Retinal fundus photograph:
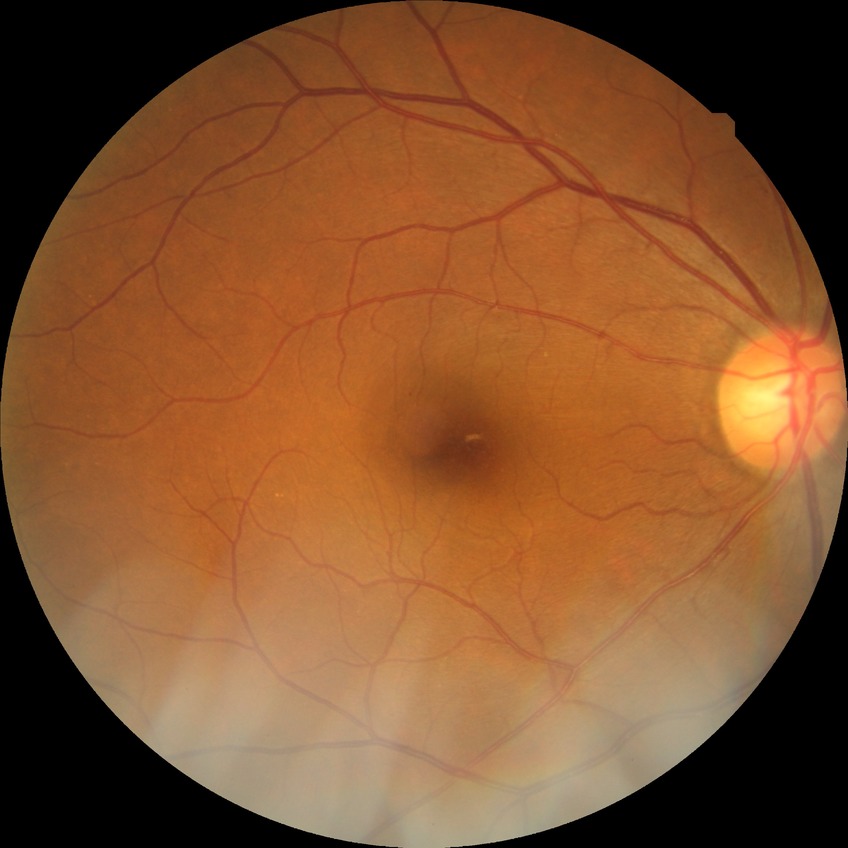
diabetic retinopathy (DR)=simple diabetic retinopathy (SDR).